NIDEK AFC-230 fundus camera, Davis DR grading.
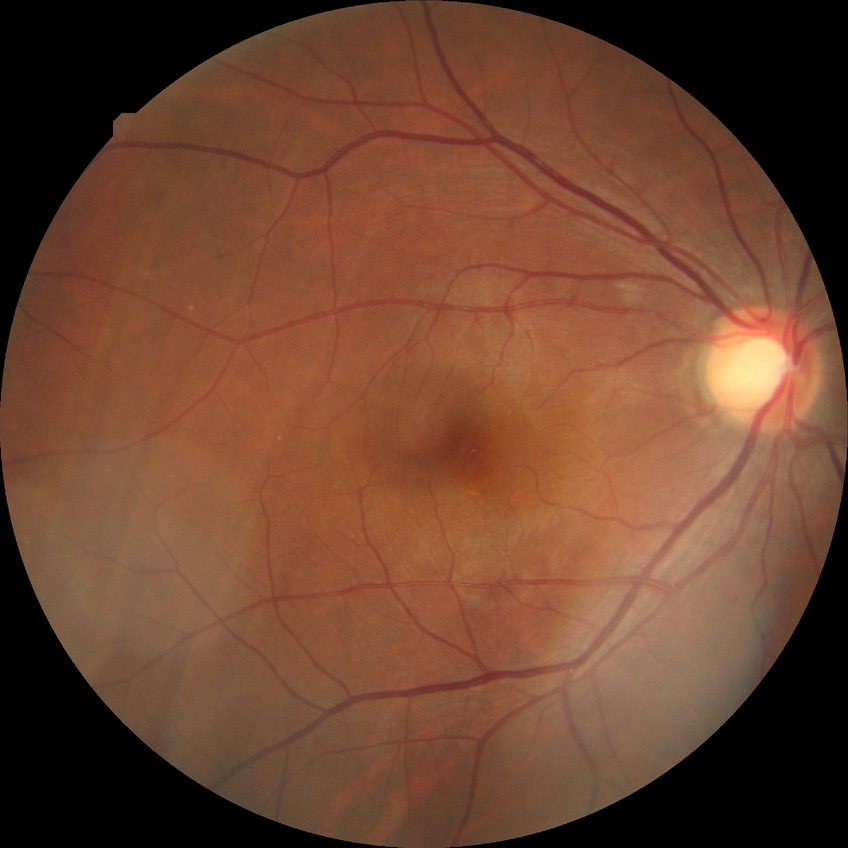   davis_grade: NDR